Modified Davis classification
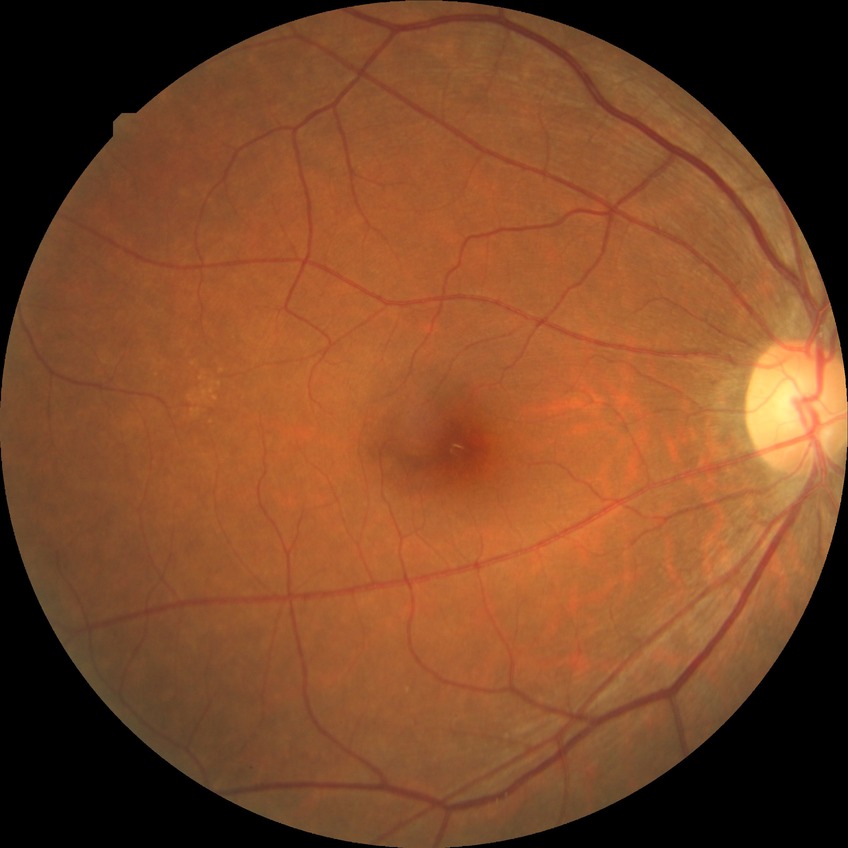
DR: NDR.